CFP — 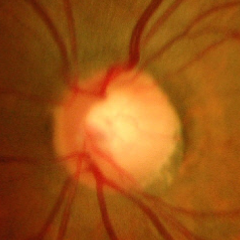

The image shows advanced glaucoma.